Color fundus photograph.
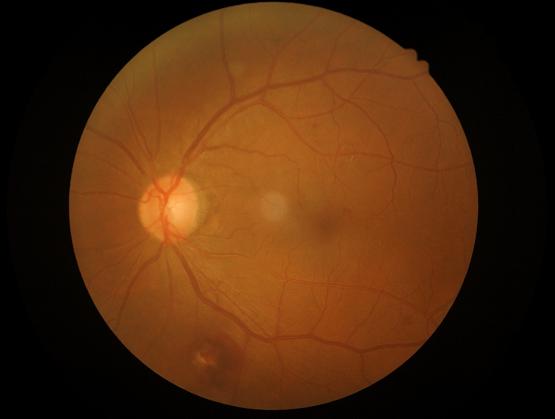
Quality grading: overall: adequate for clinical interpretation; contrast: good dynamic range; illumination: no over- or under-exposure; sharpness: optic disc, vessels, and background in focus.